2212 by 1661 pixels. Age 76.
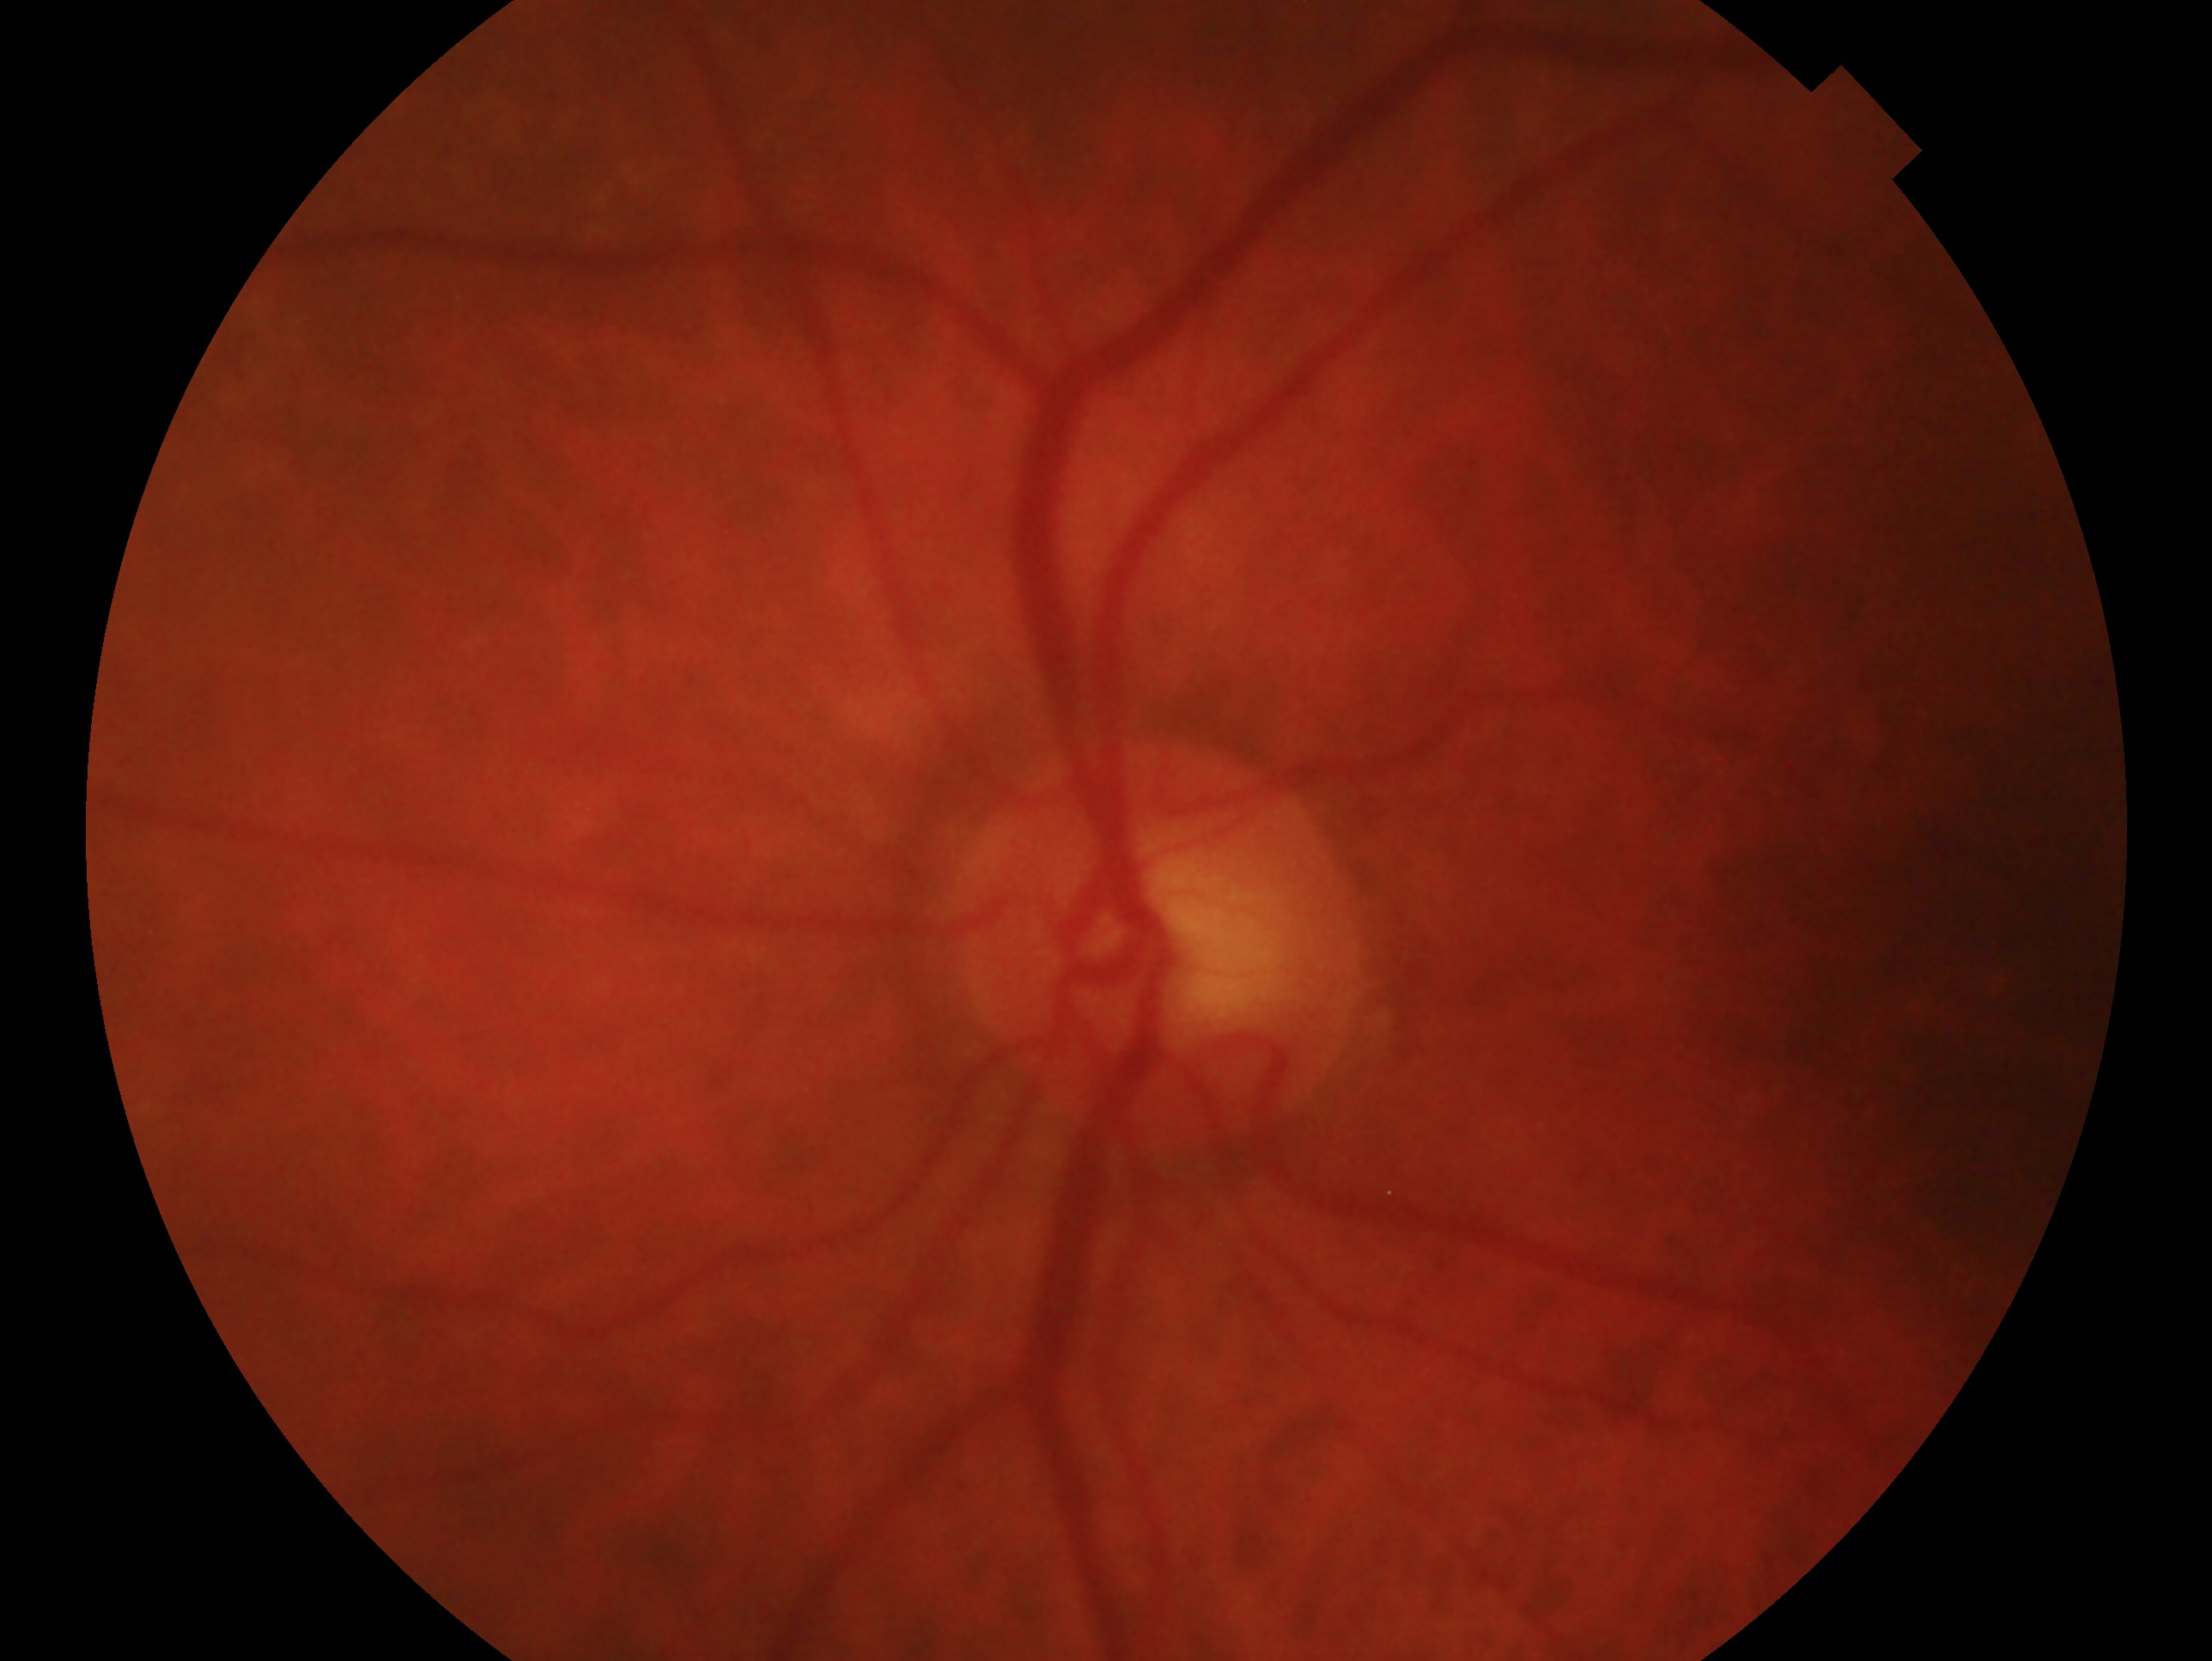
• laterality — left
• glaucoma diagnosis — no glaucomatous findings — no clinical evidence of glaucoma in this eye